NIDEK AFC-230. Graded on the modified Davis scale. 45° field of view — 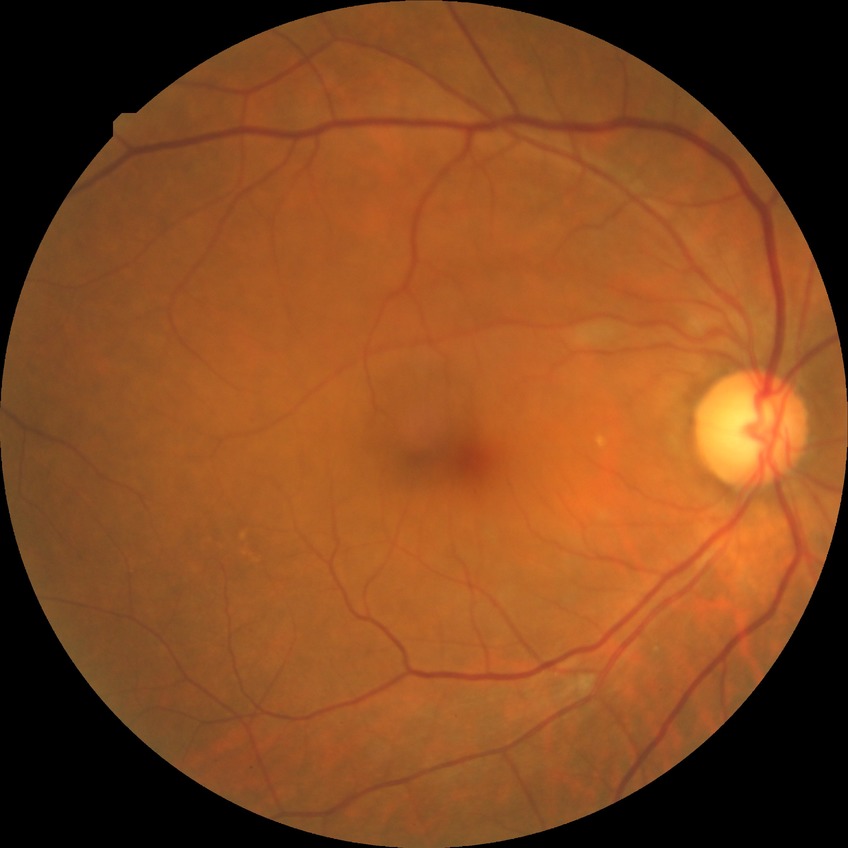
modified Davis grade: NDR